Centered on the optic disc; undilated pupil; color fundus photograph
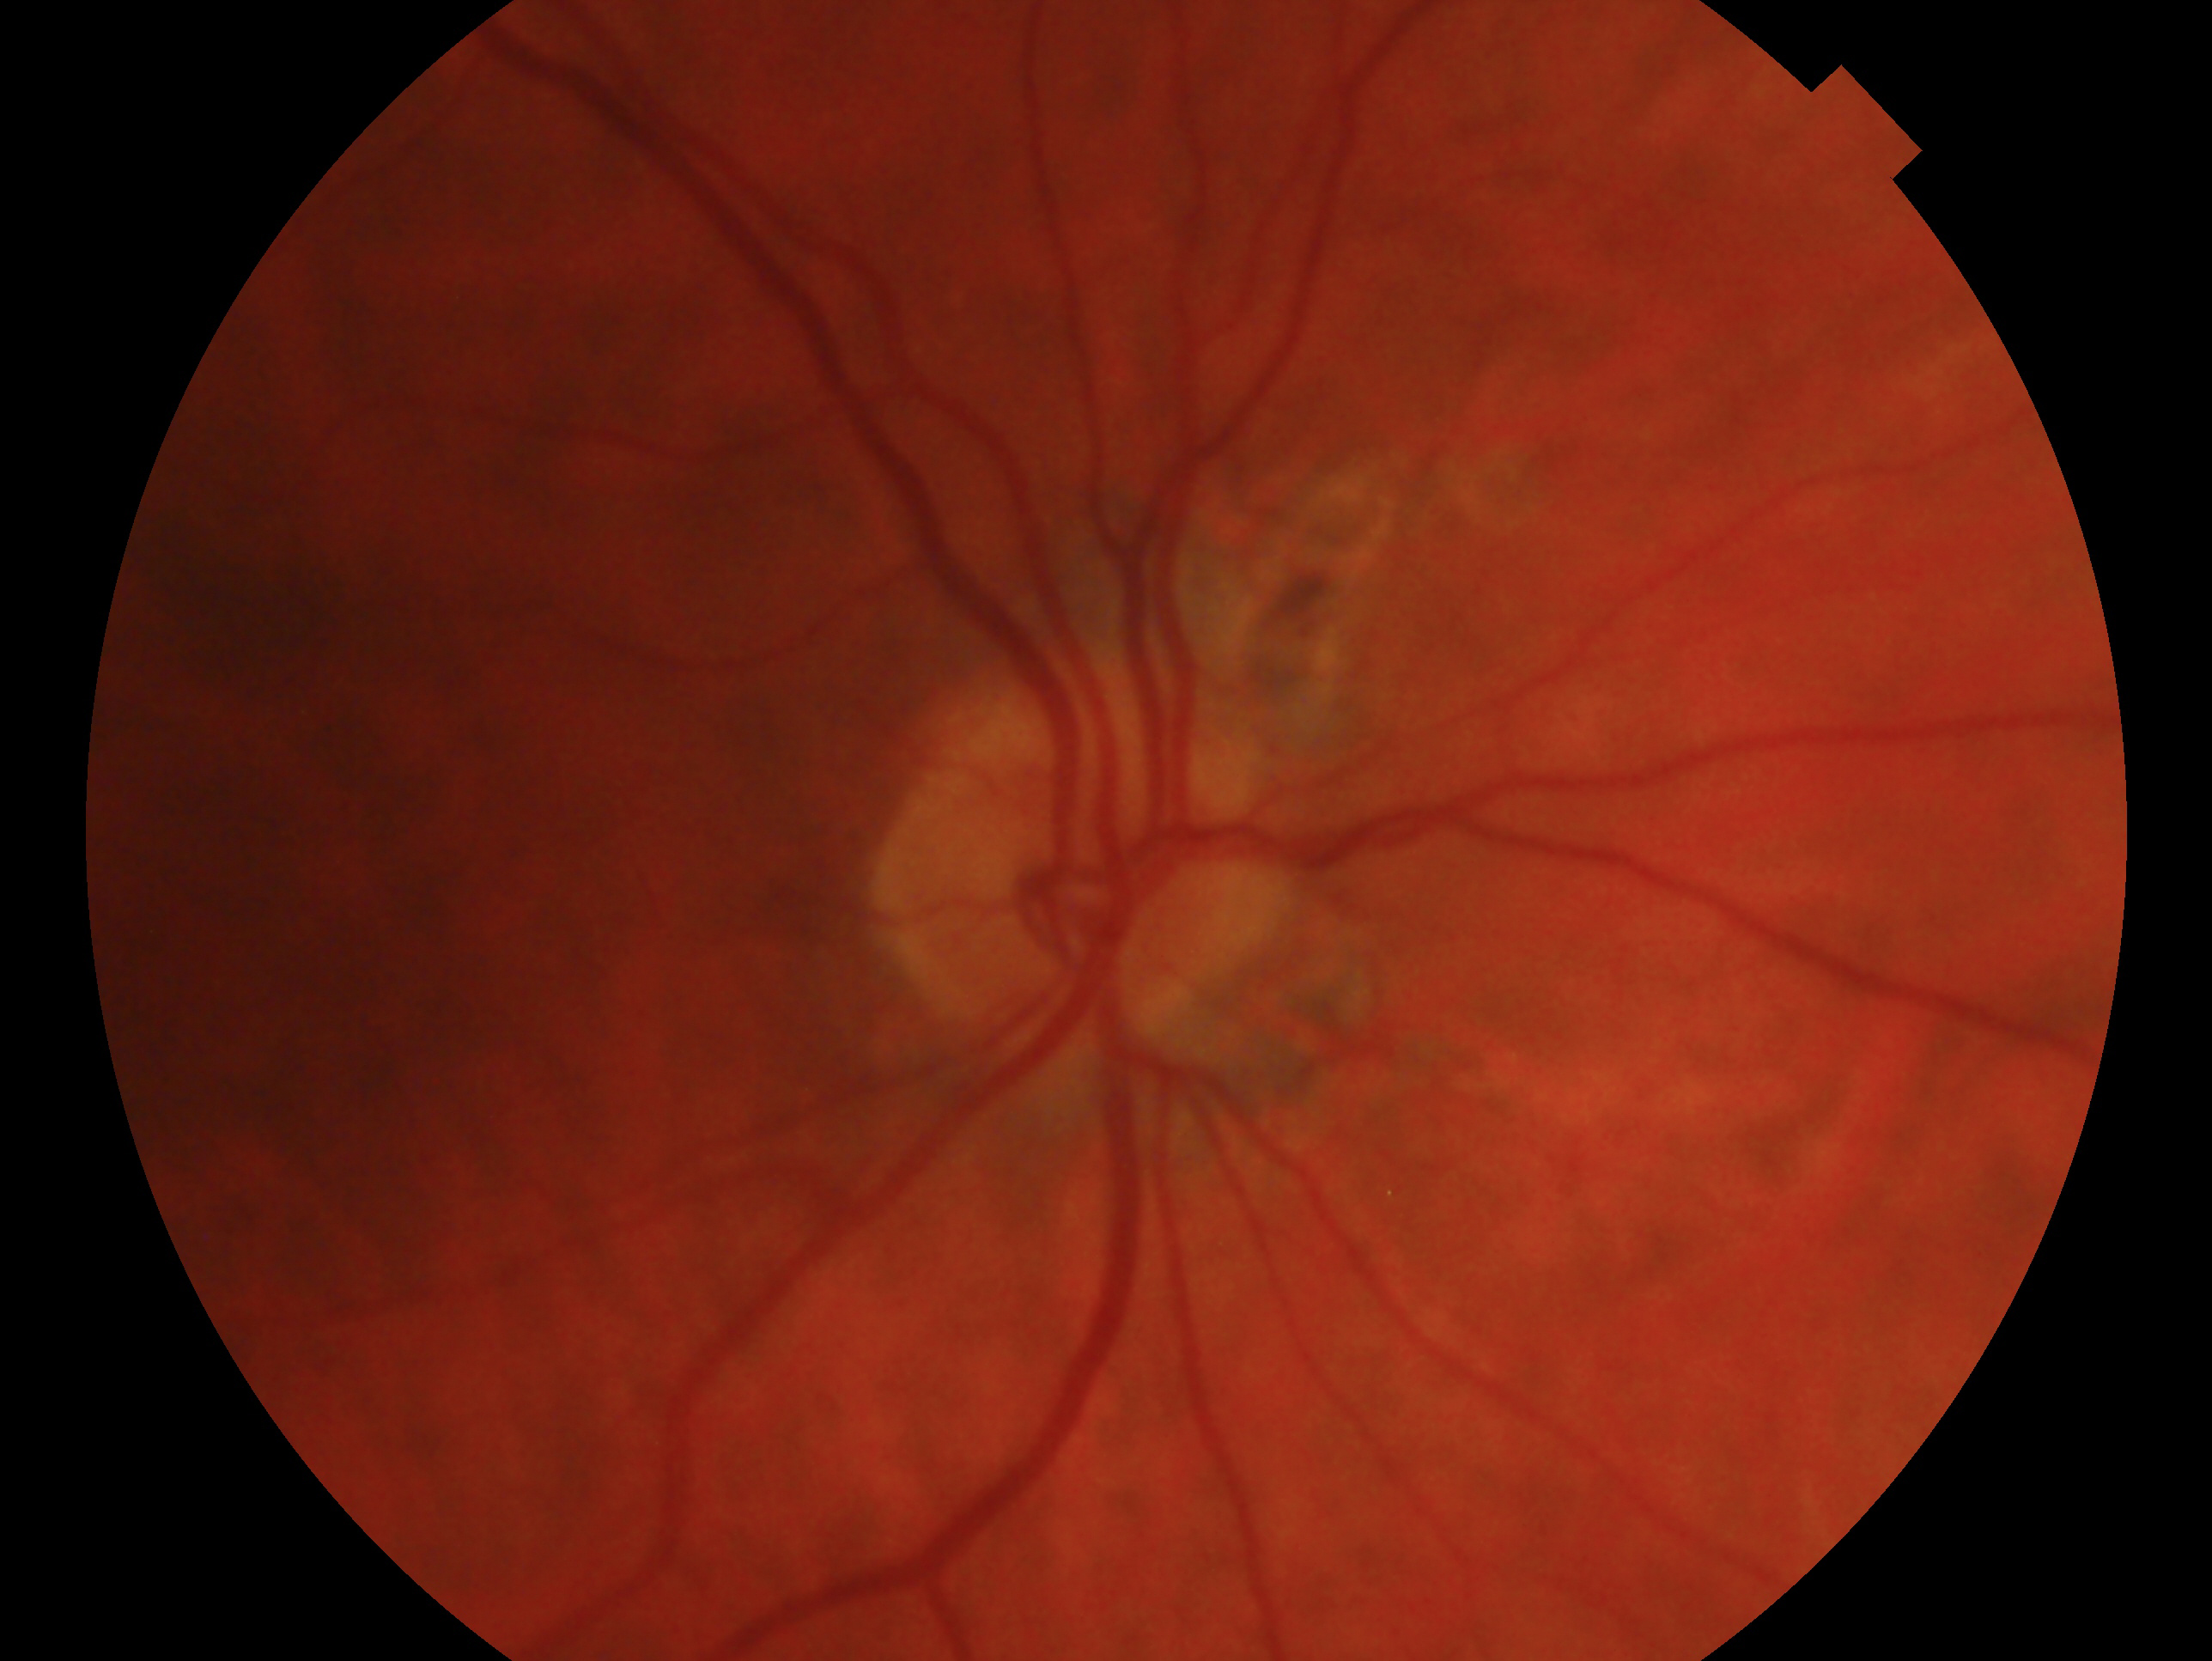 {"eye": "oculus dexter", "glaucoma_dx": "consistent with glaucoma"}